Wide-field contact fundus photograph of an infant — 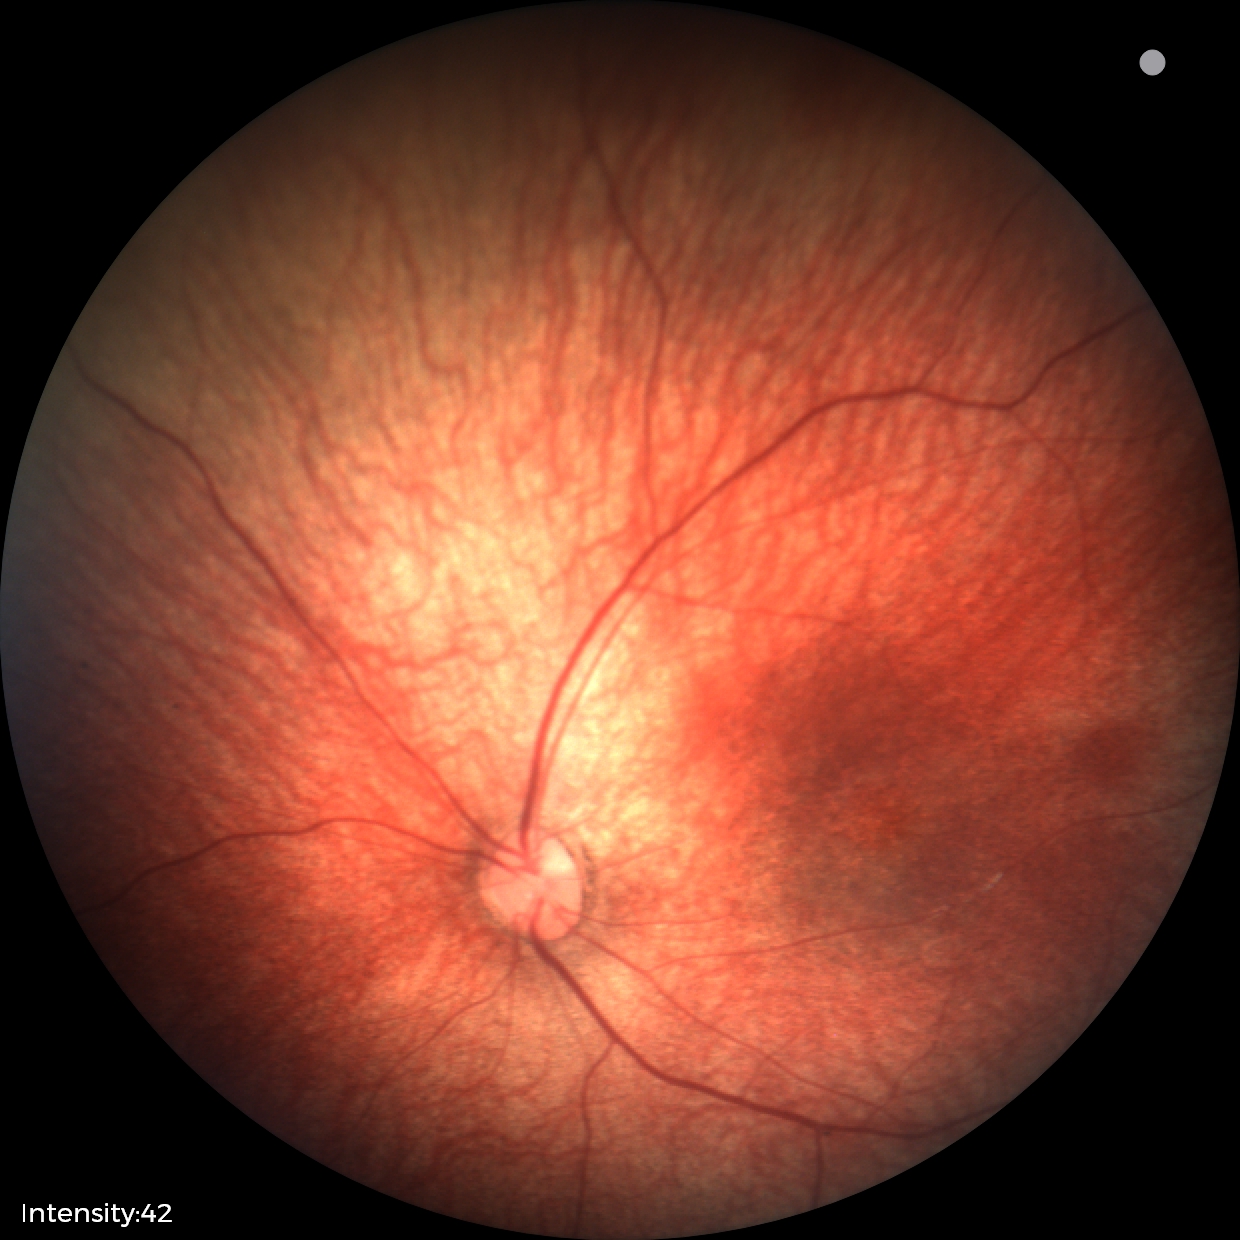 Screening examination with no abnormal retinal findings.